2228x1652px; retinal fundus photograph.
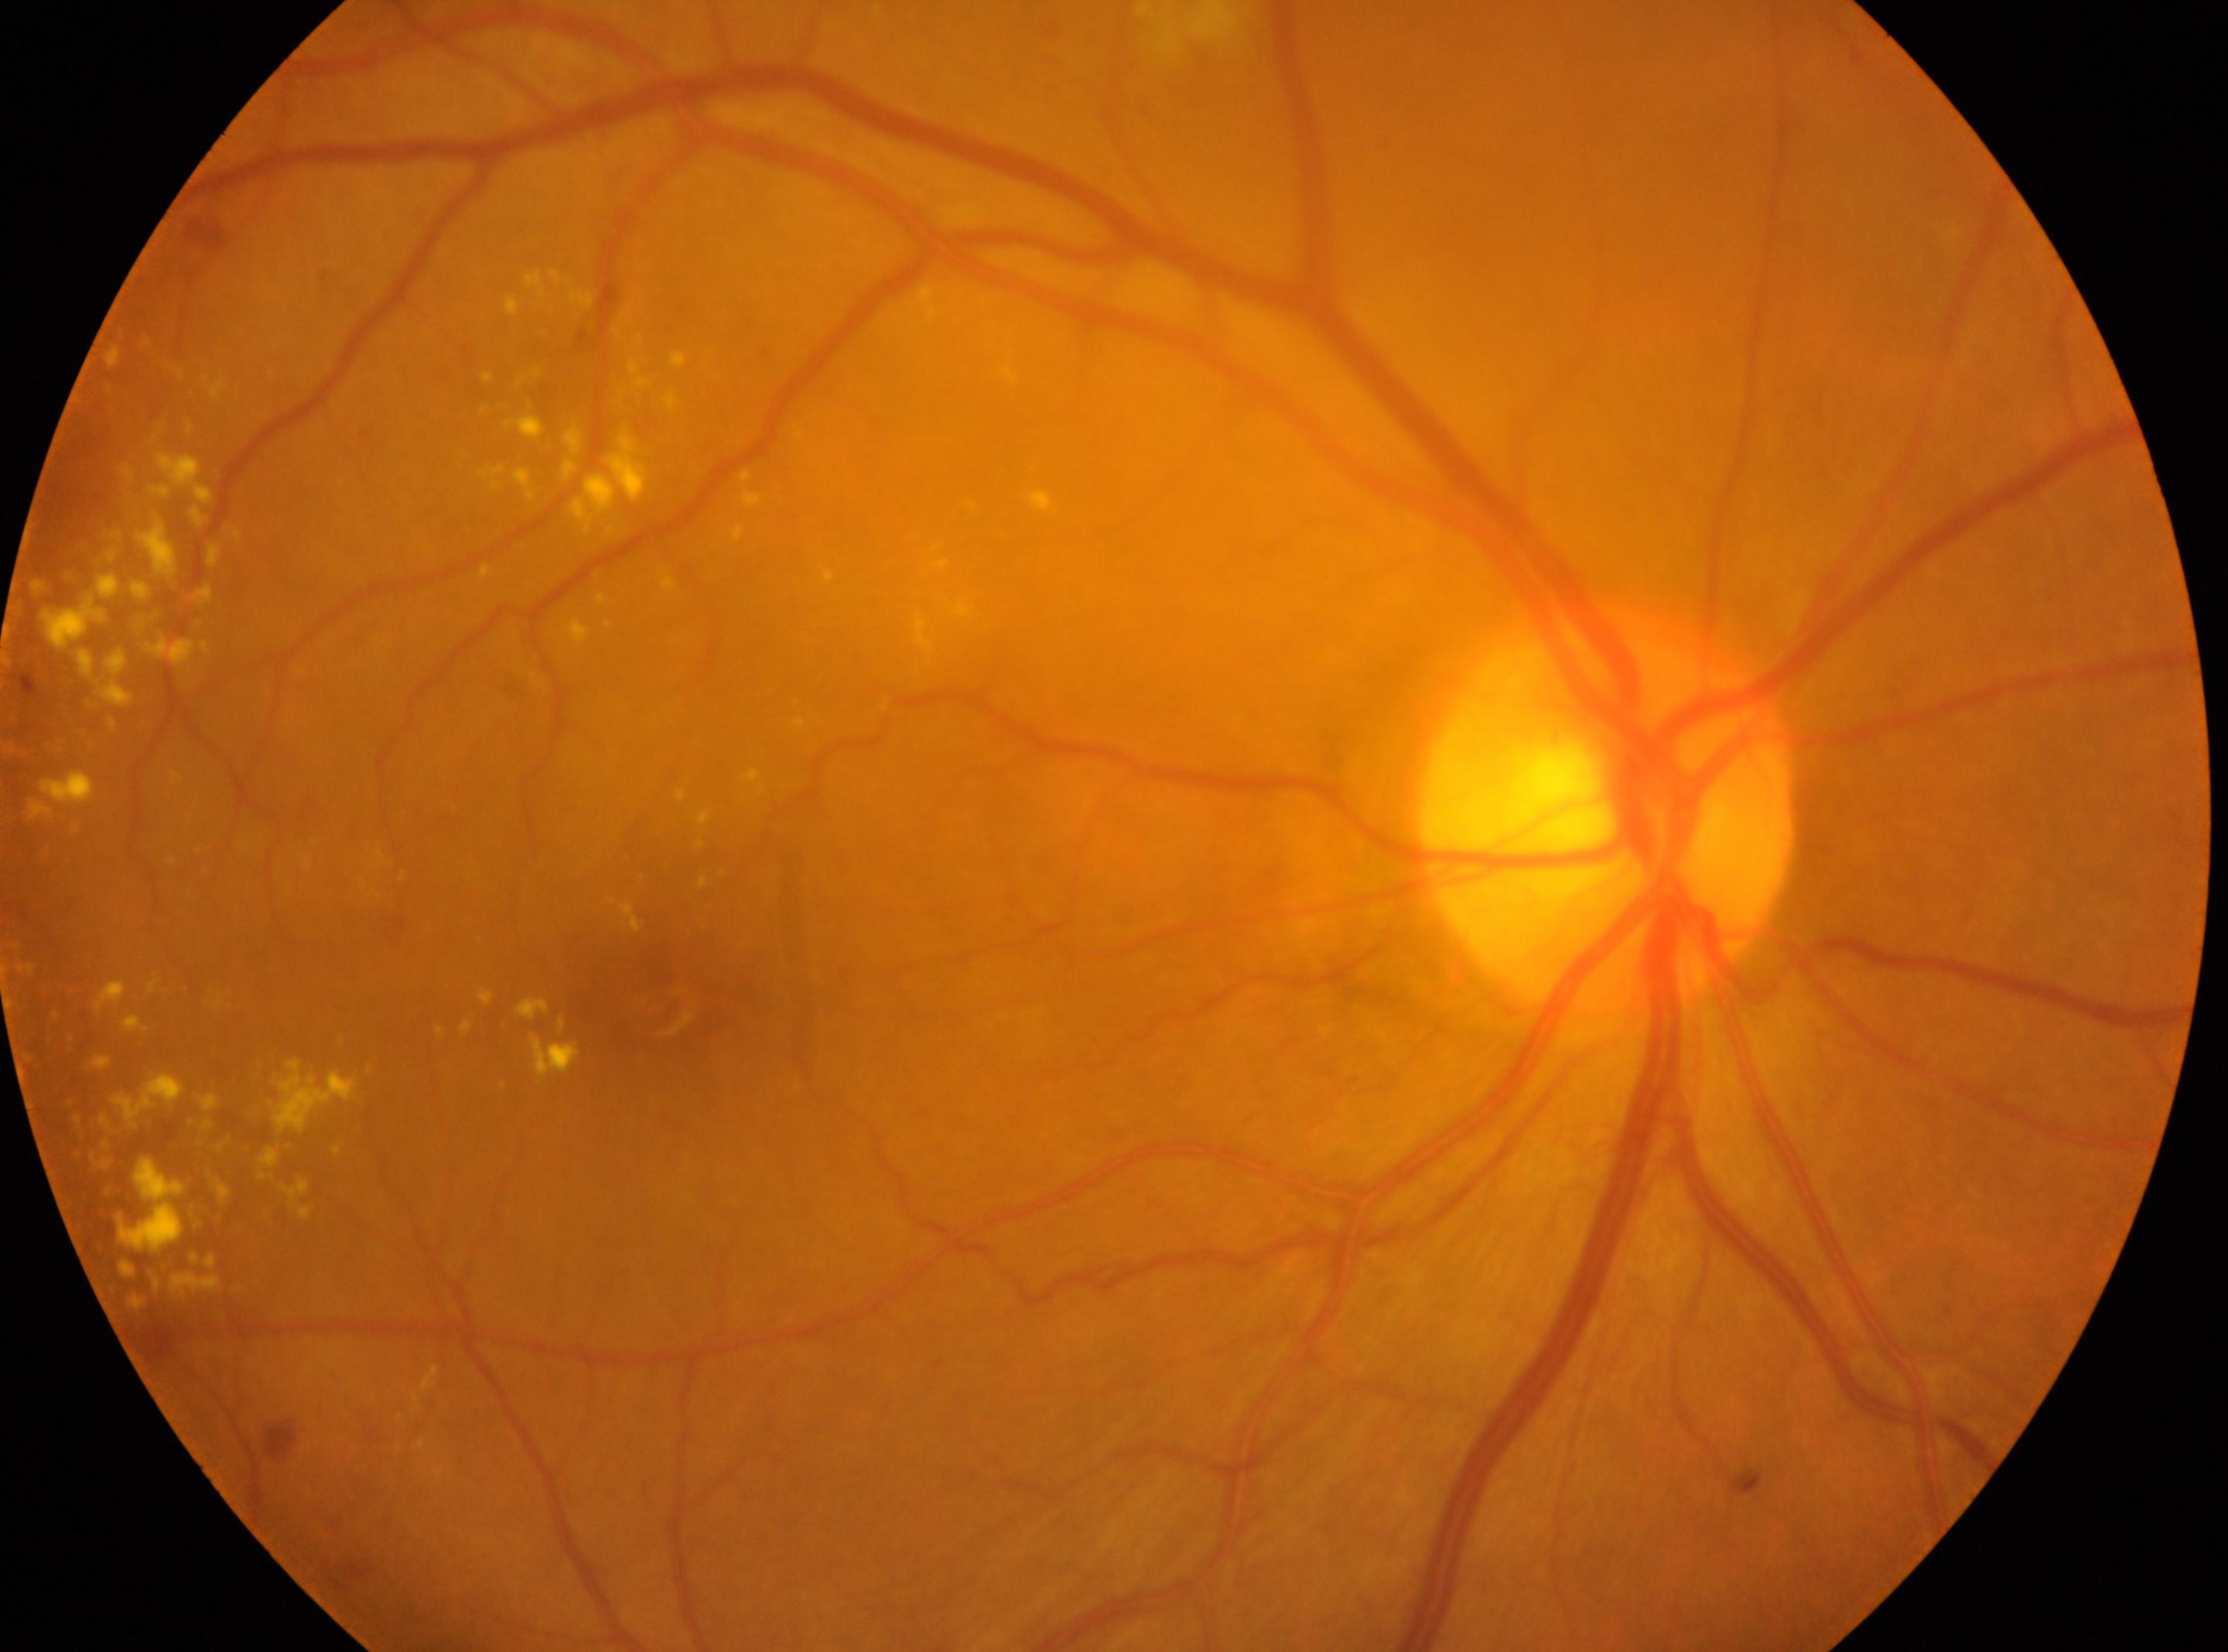

Optic disc: x=1608, y=811.
This is the right eye.
The fovea is at x=662, y=1012.
DR grade is 2.